Ultra-widefield fundus mosaic · FOV: 200 degrees:
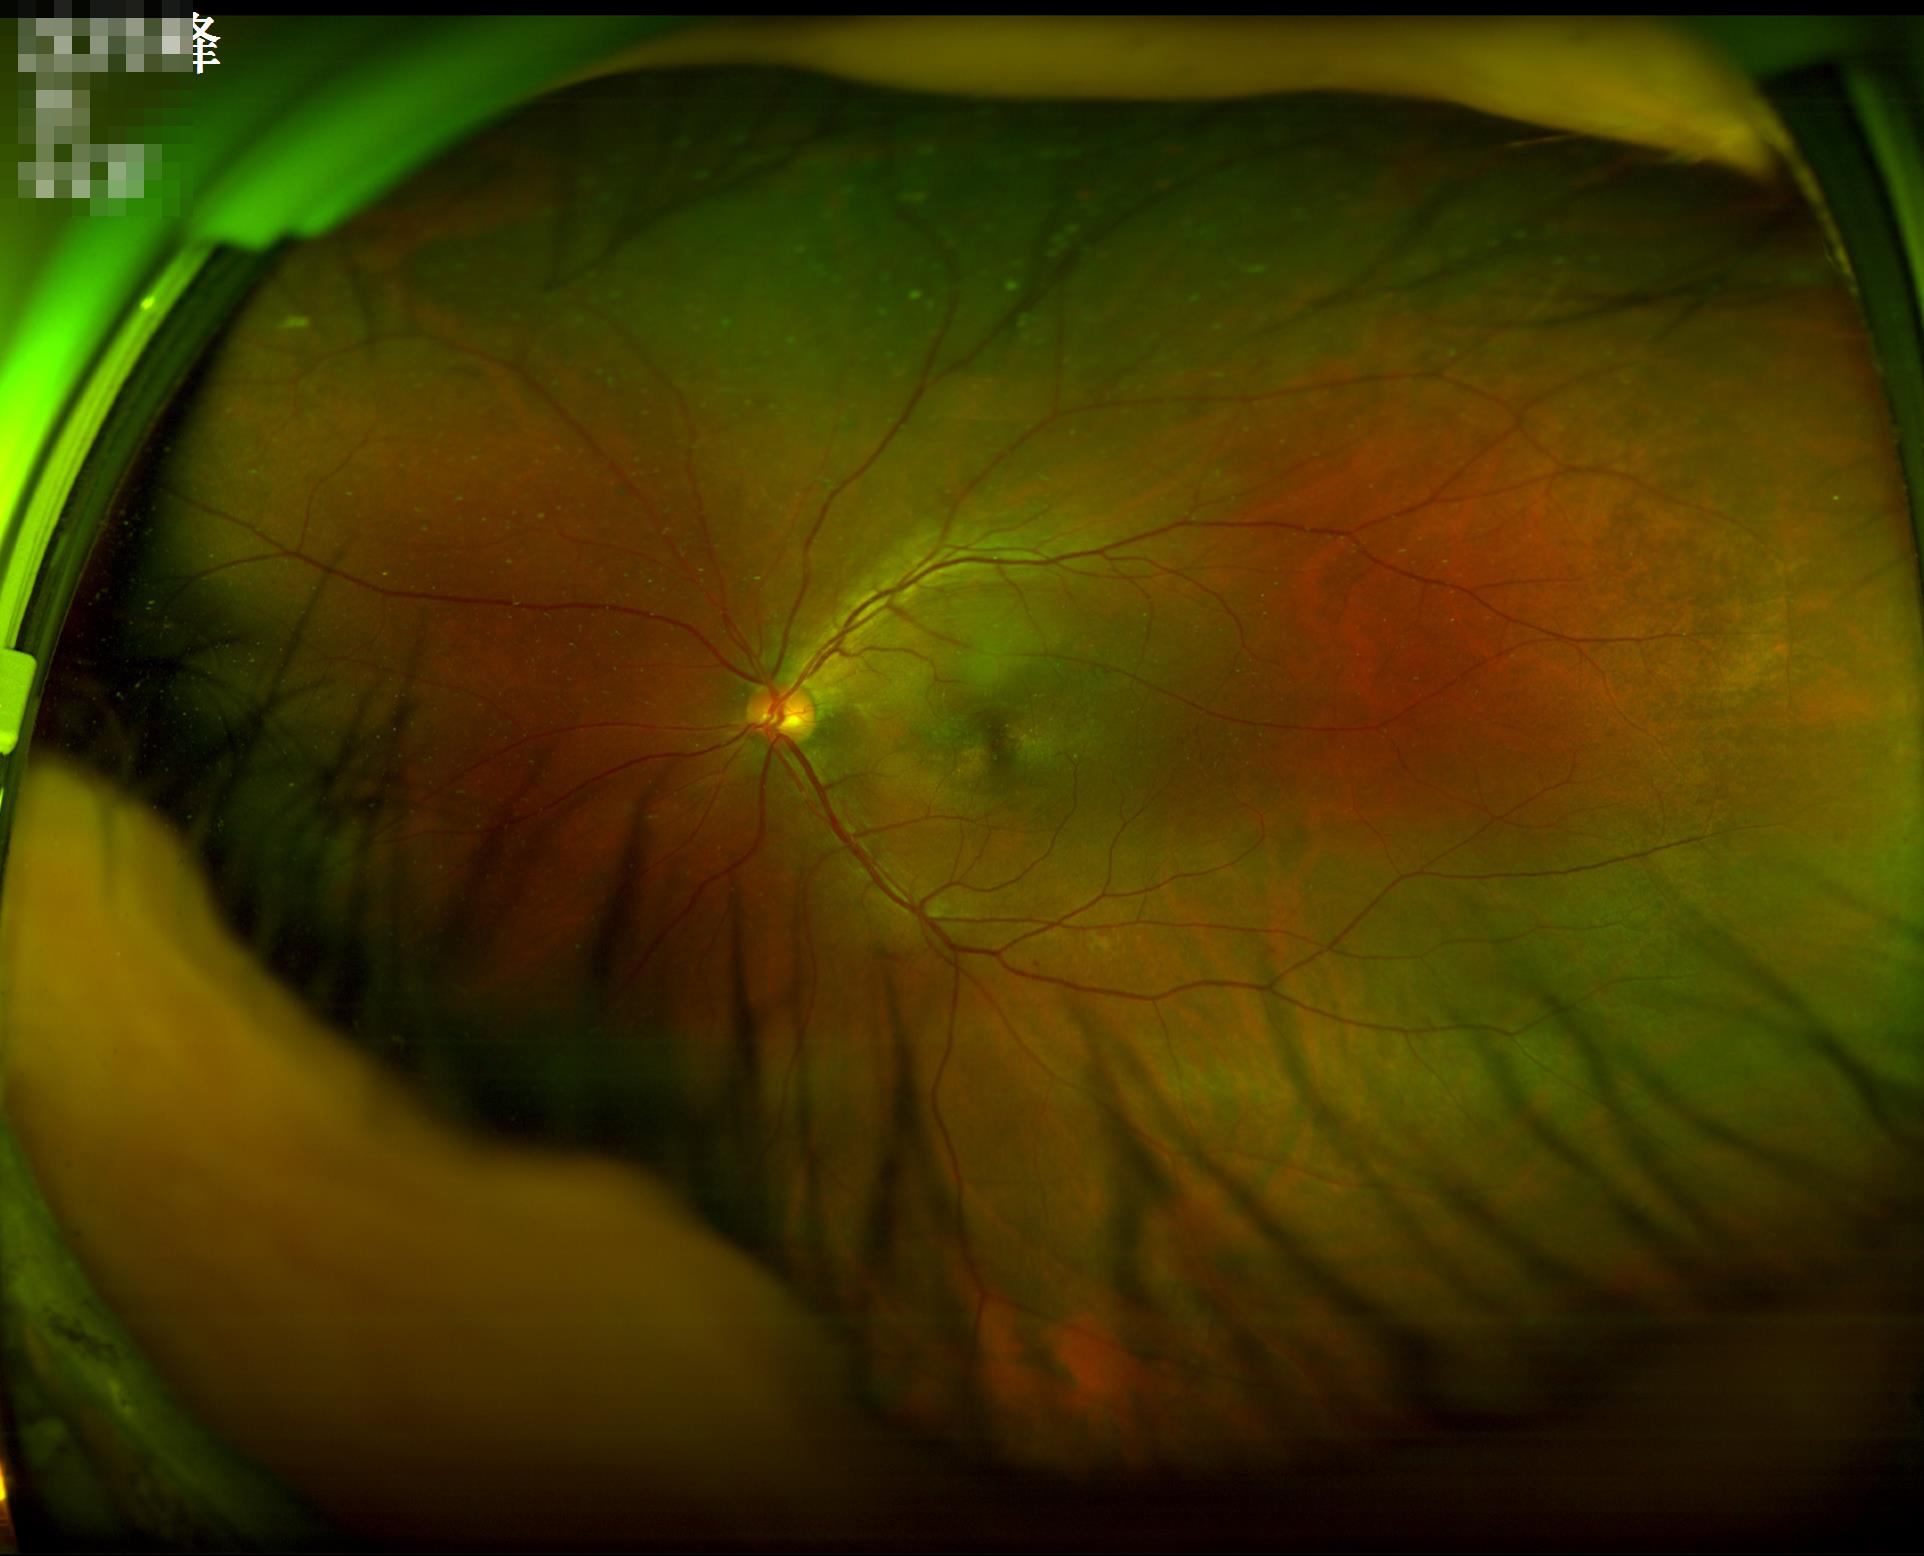

{"illumination": "over- or under-exposed", "clarity": "clear with no noticeable blur"}